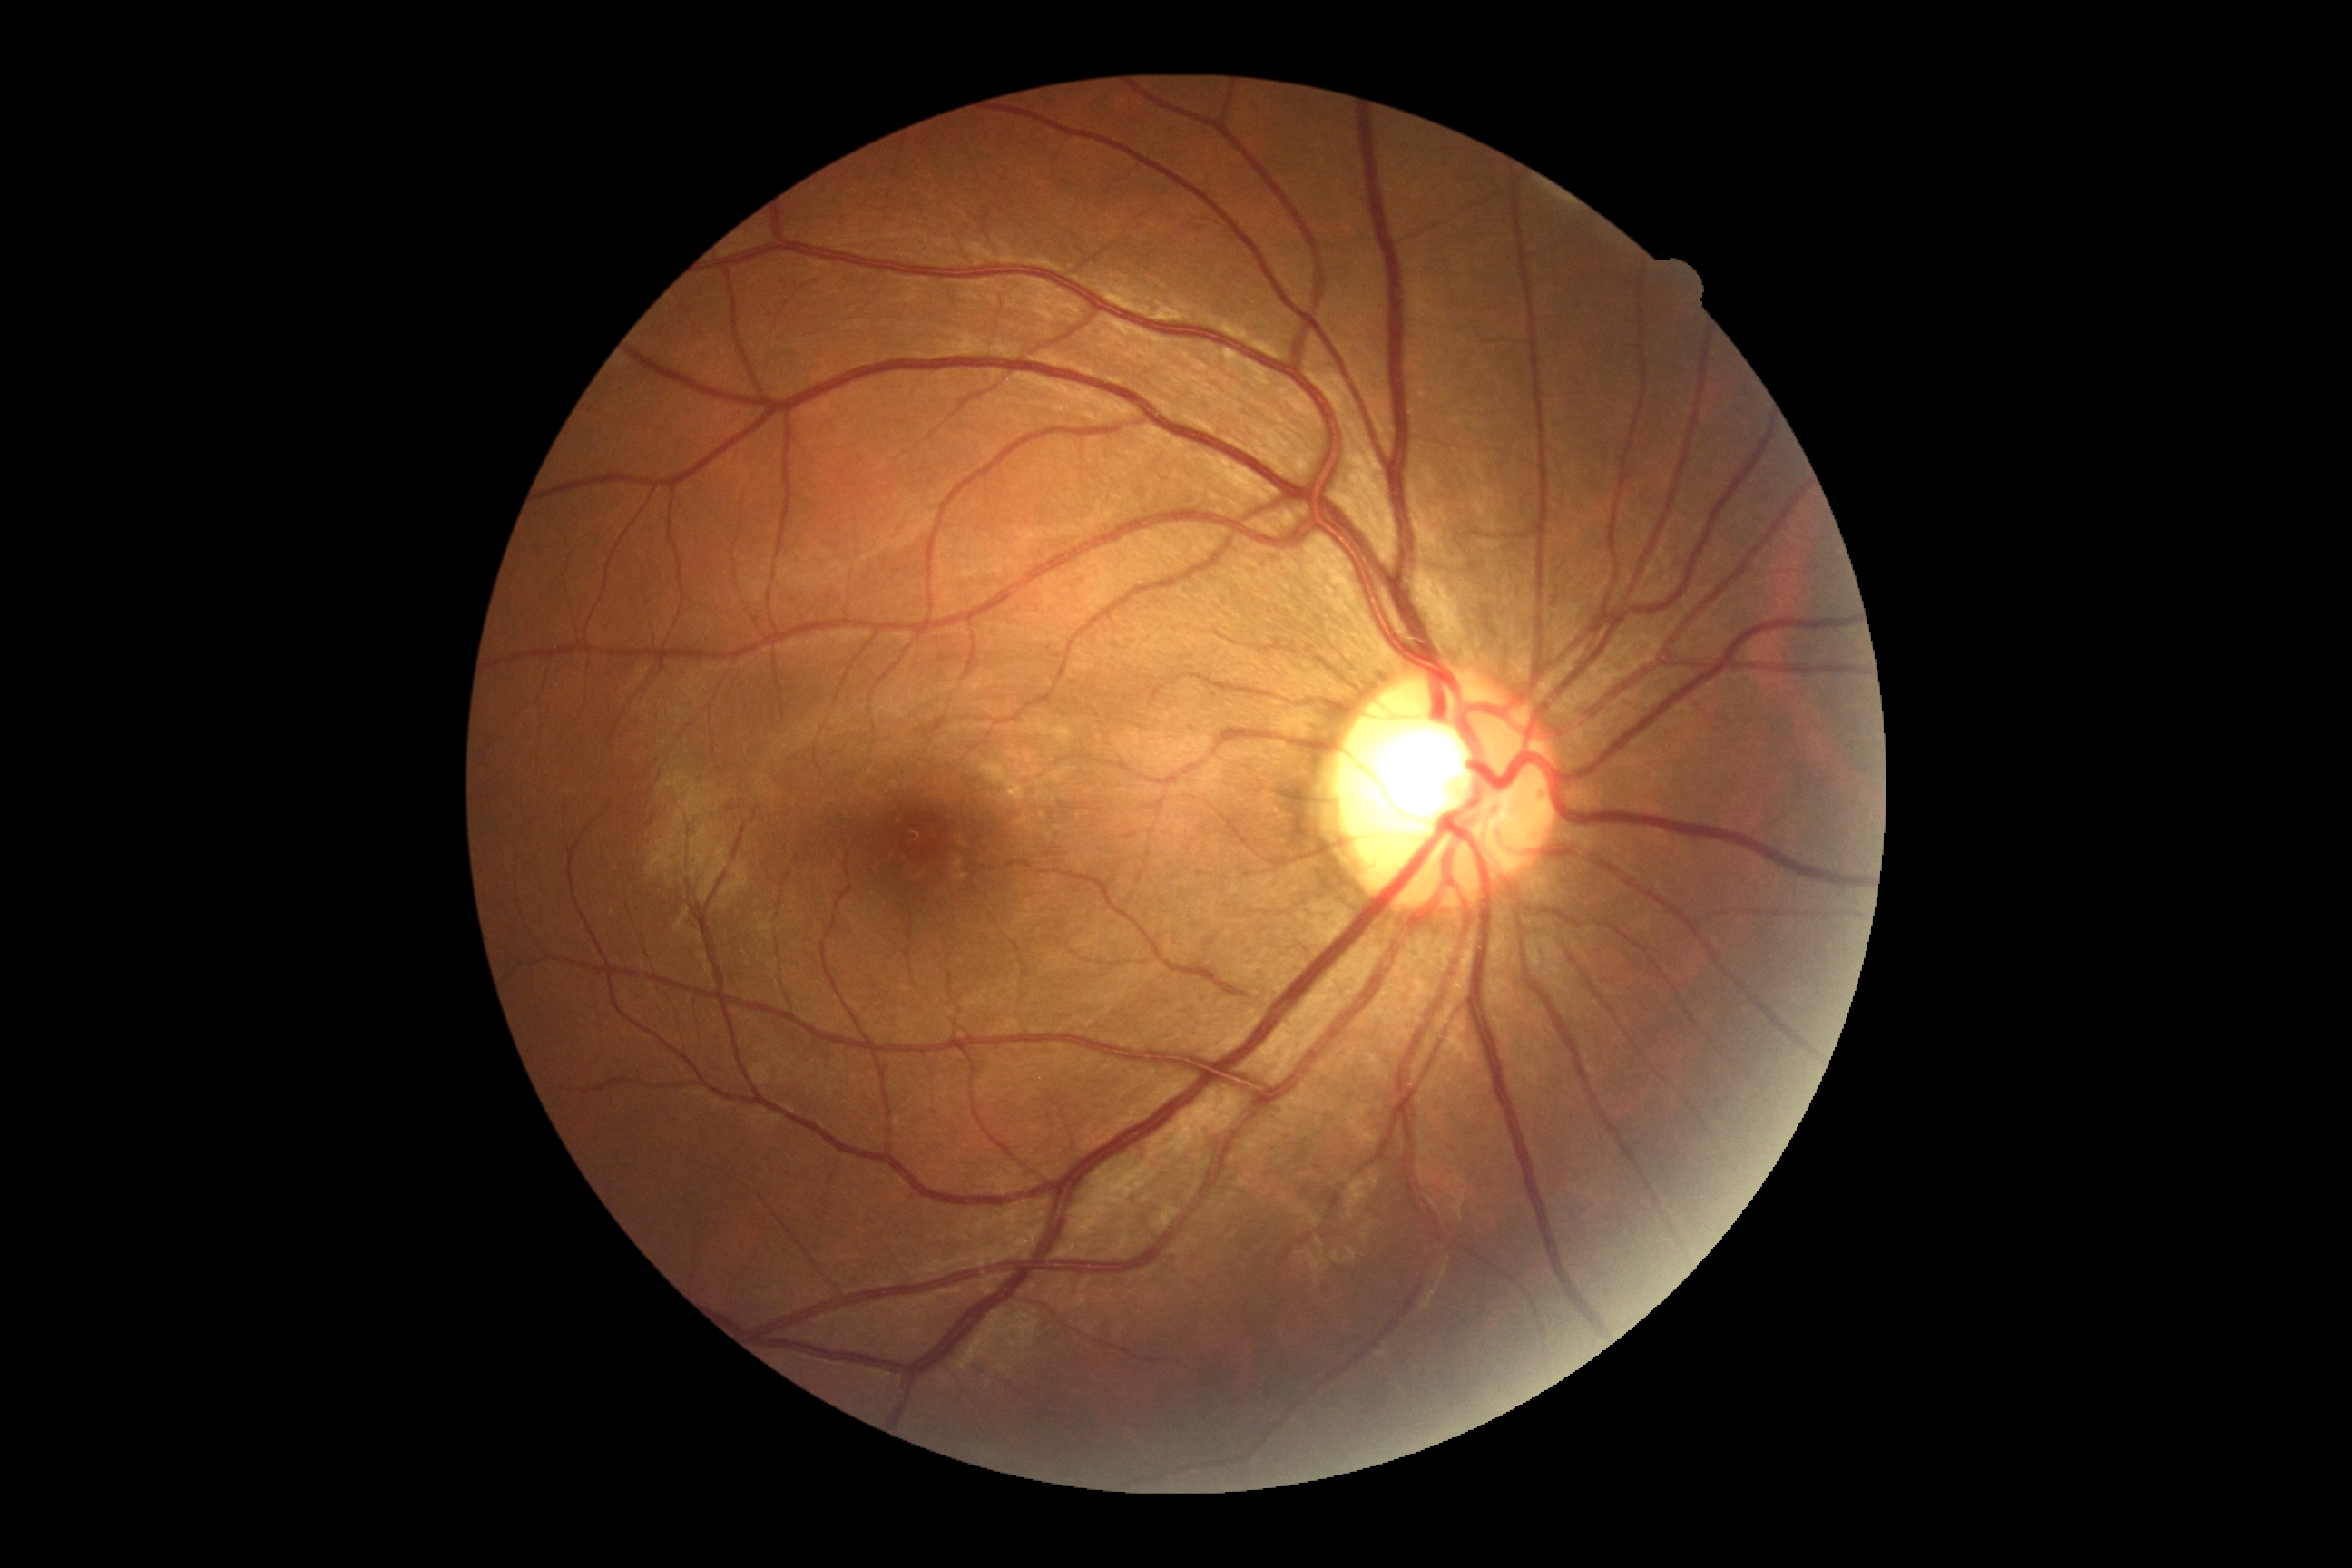 Retinopathy is 0/4.